NIDEK AFC-230: 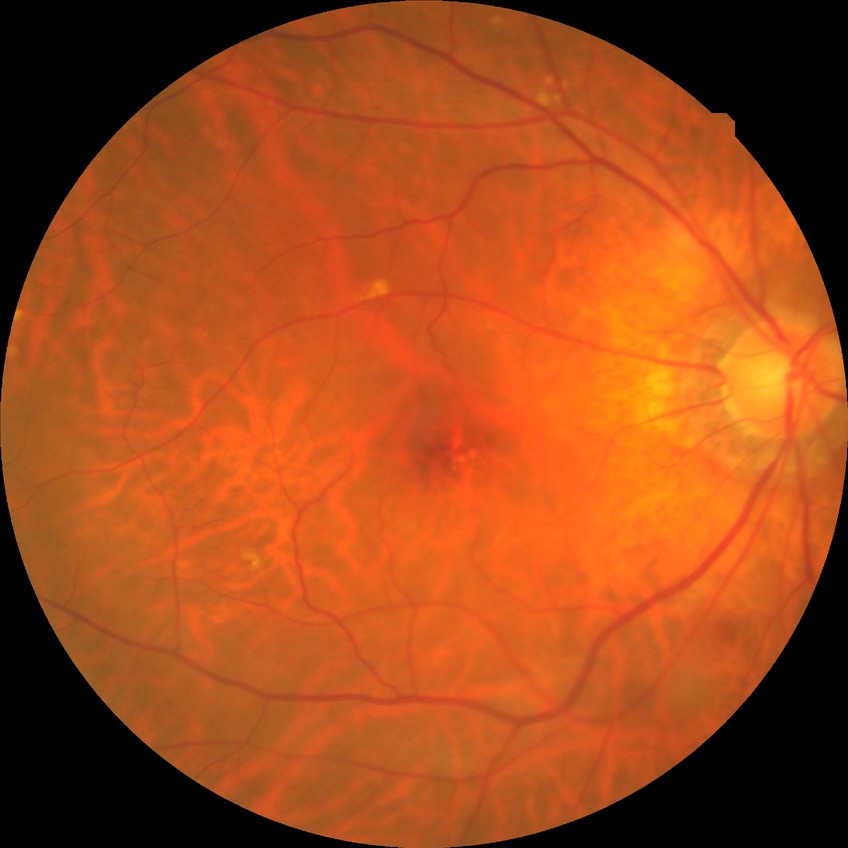
Diabetic retinopathy (DR) is no diabetic retinopathy (NDR).